Infant wide-field fundus photograph
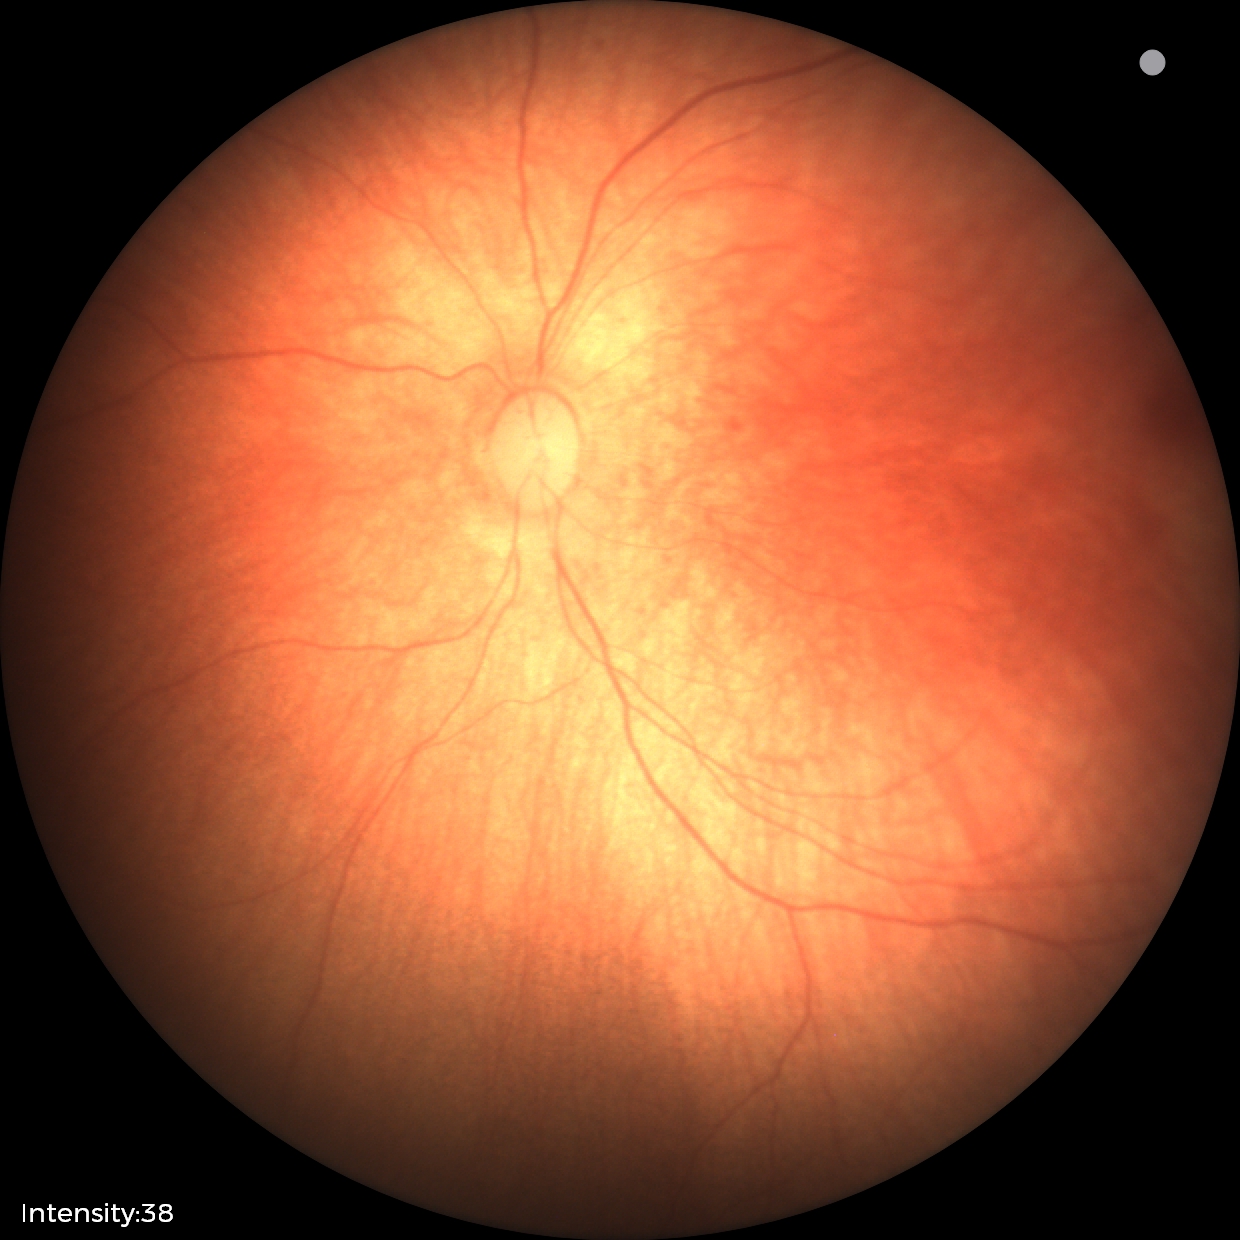 Impression: physiological finding.